Macula-centered field
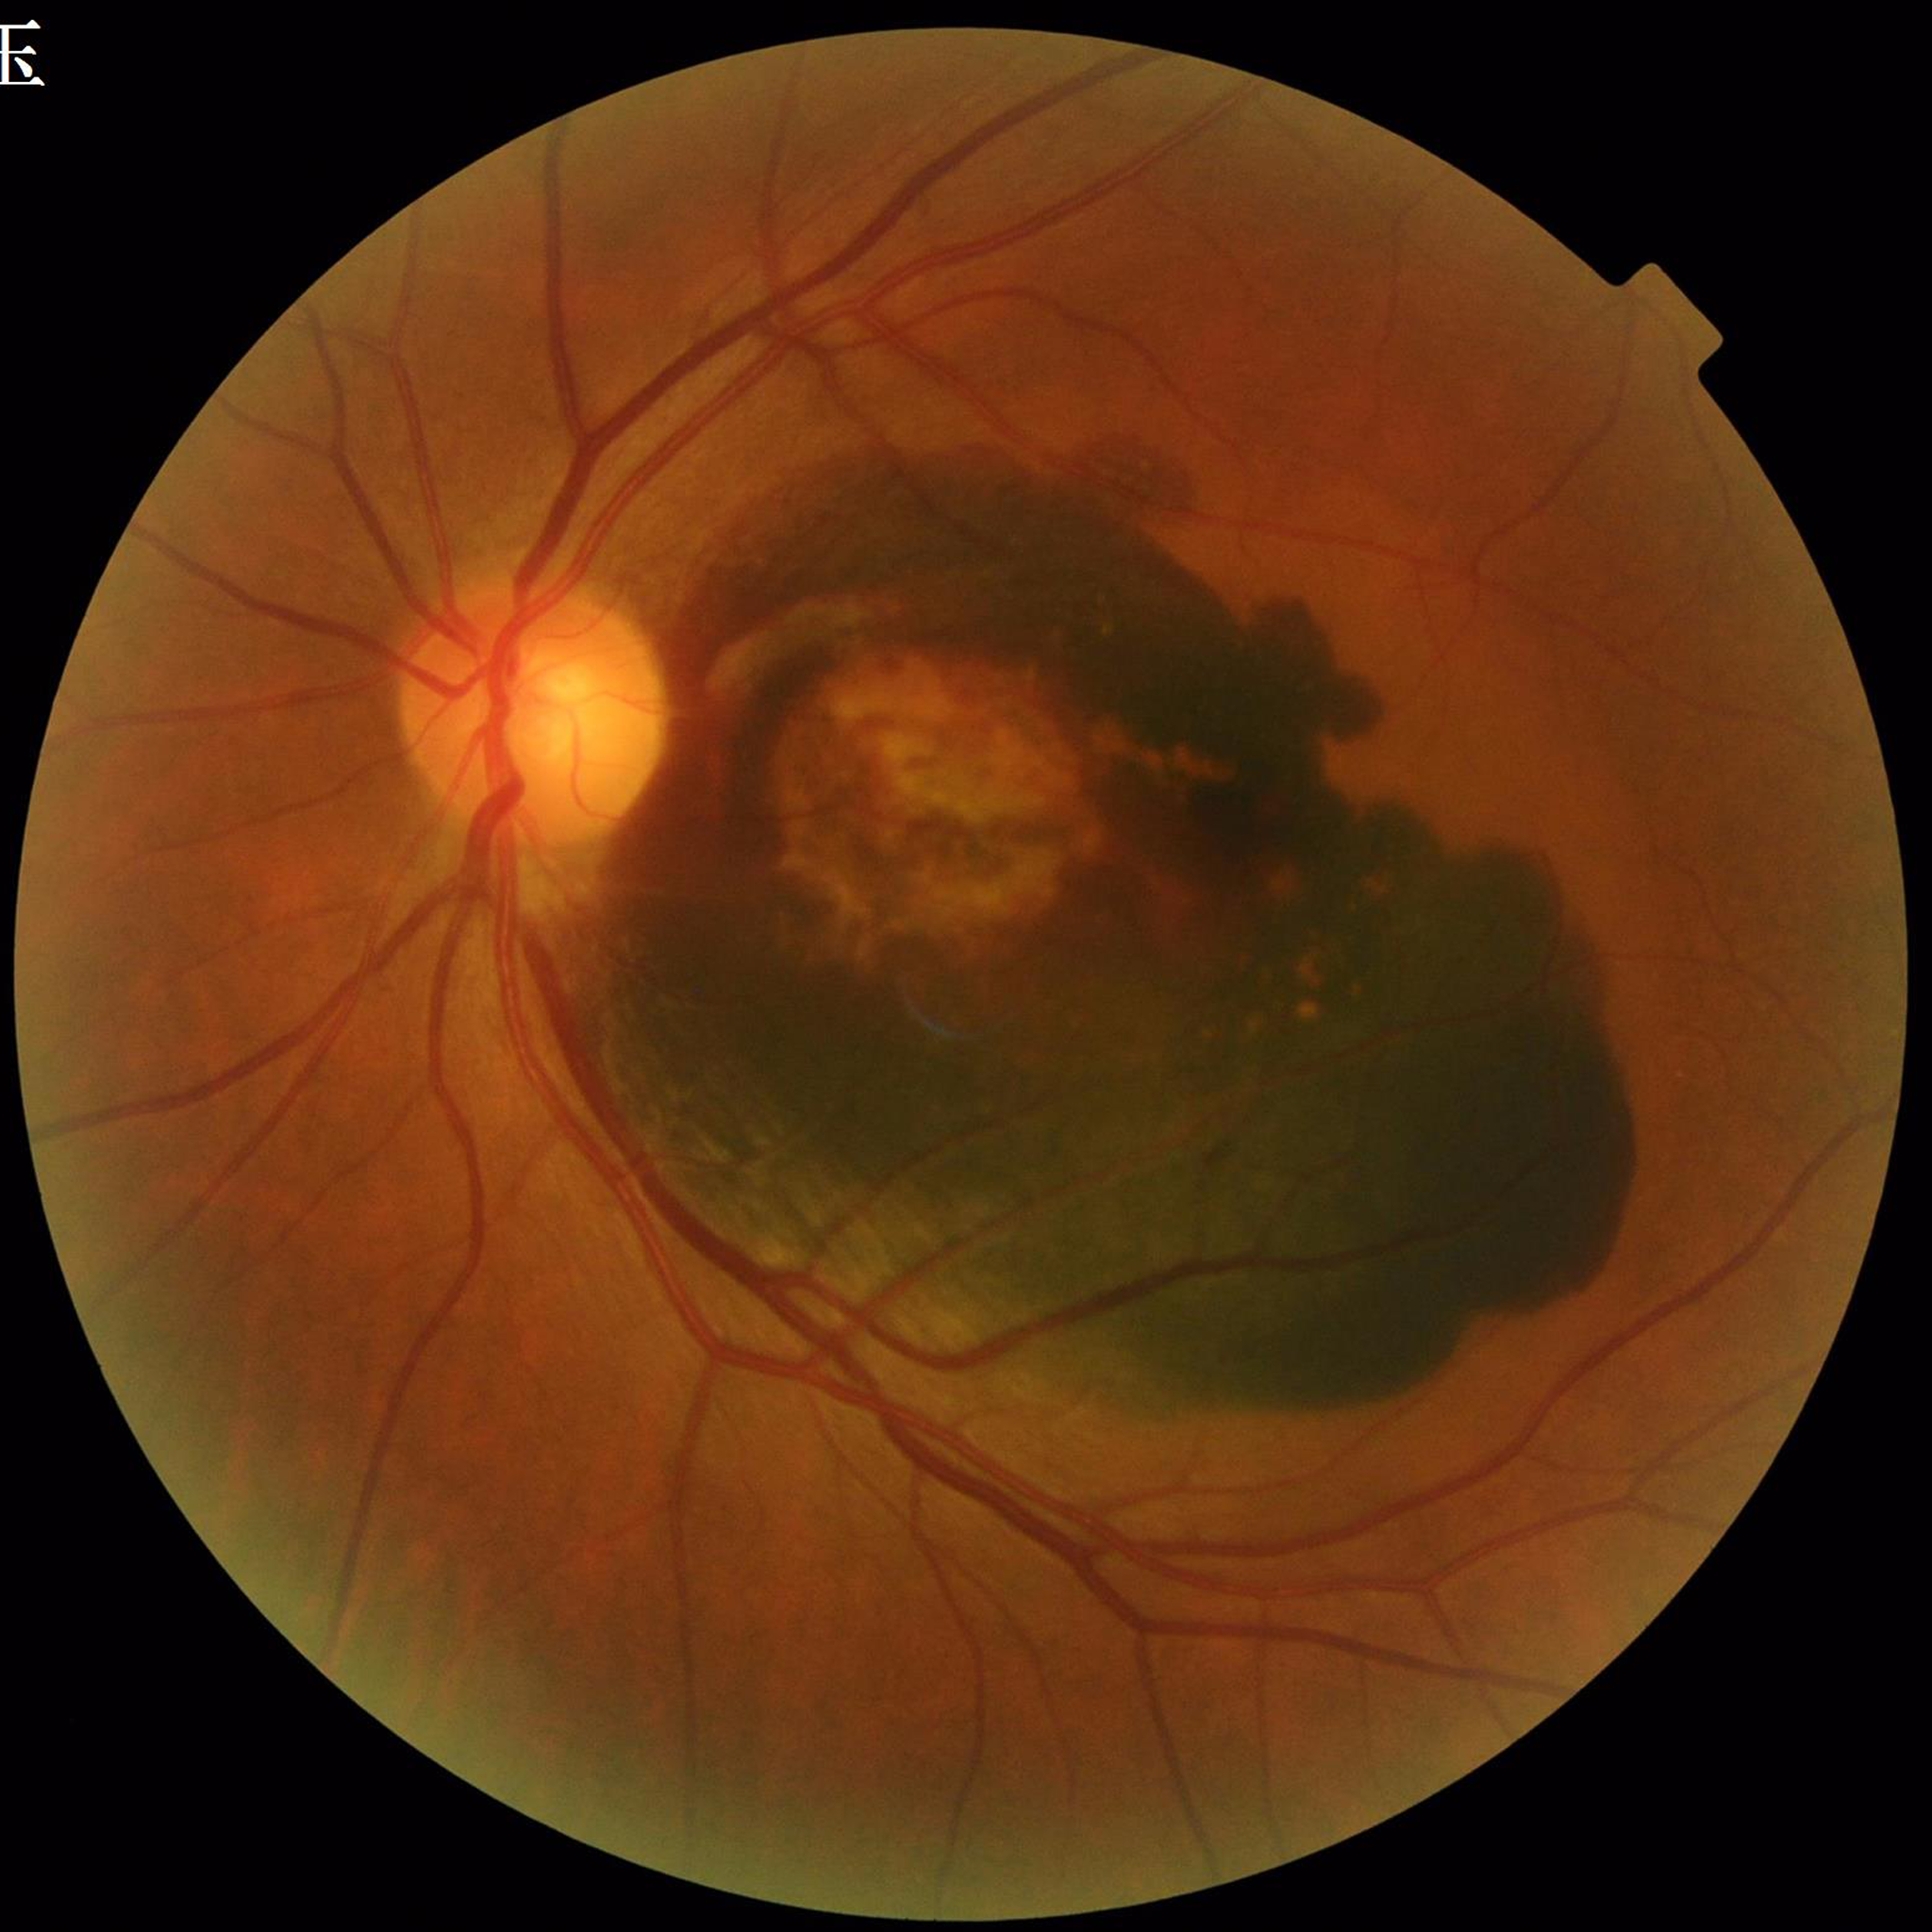 Color fundus photograph from a patient diagnosed with AMD. Image quality: no blur, illumination/color distortion present, contrast adequate.